Nonmydriatic.
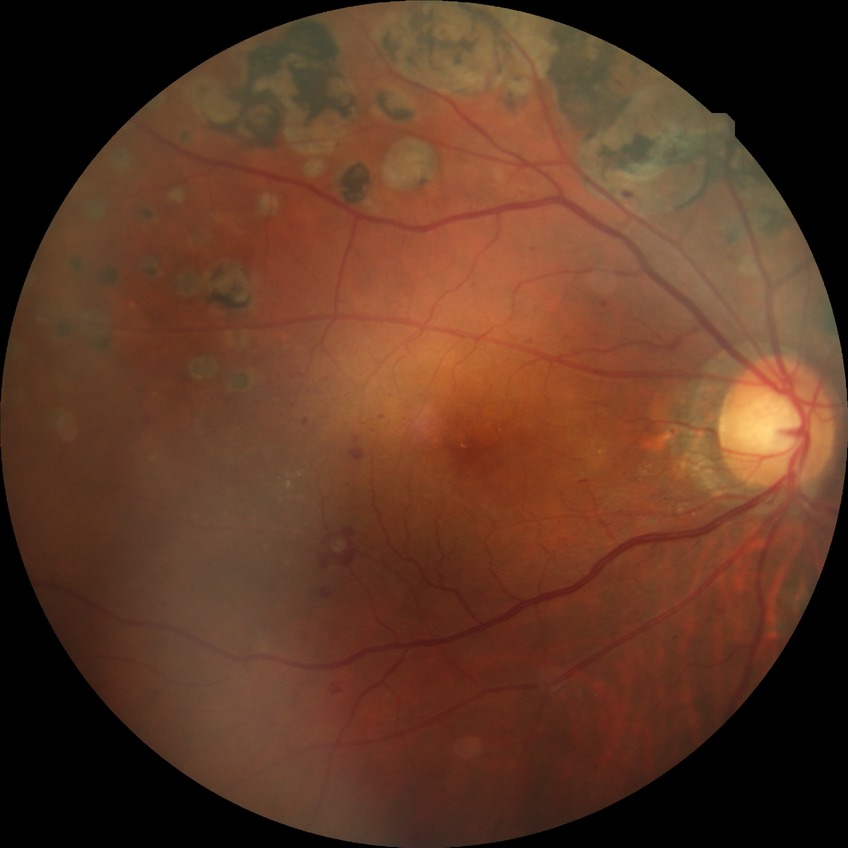 Davis grade is PDR.